Fundus photo
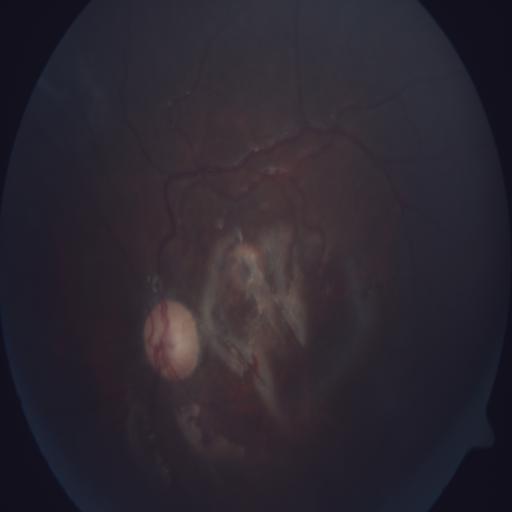 Diagnoses:
- tortuous vessels